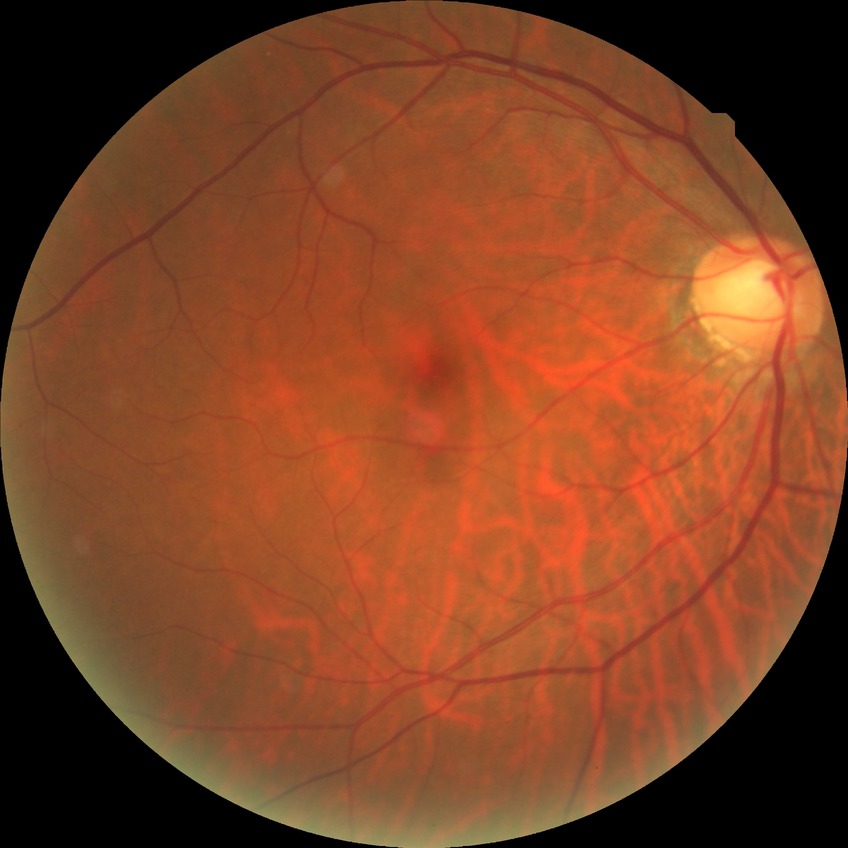

Diabetic retinopathy (DR) is NDR (no diabetic retinopathy).